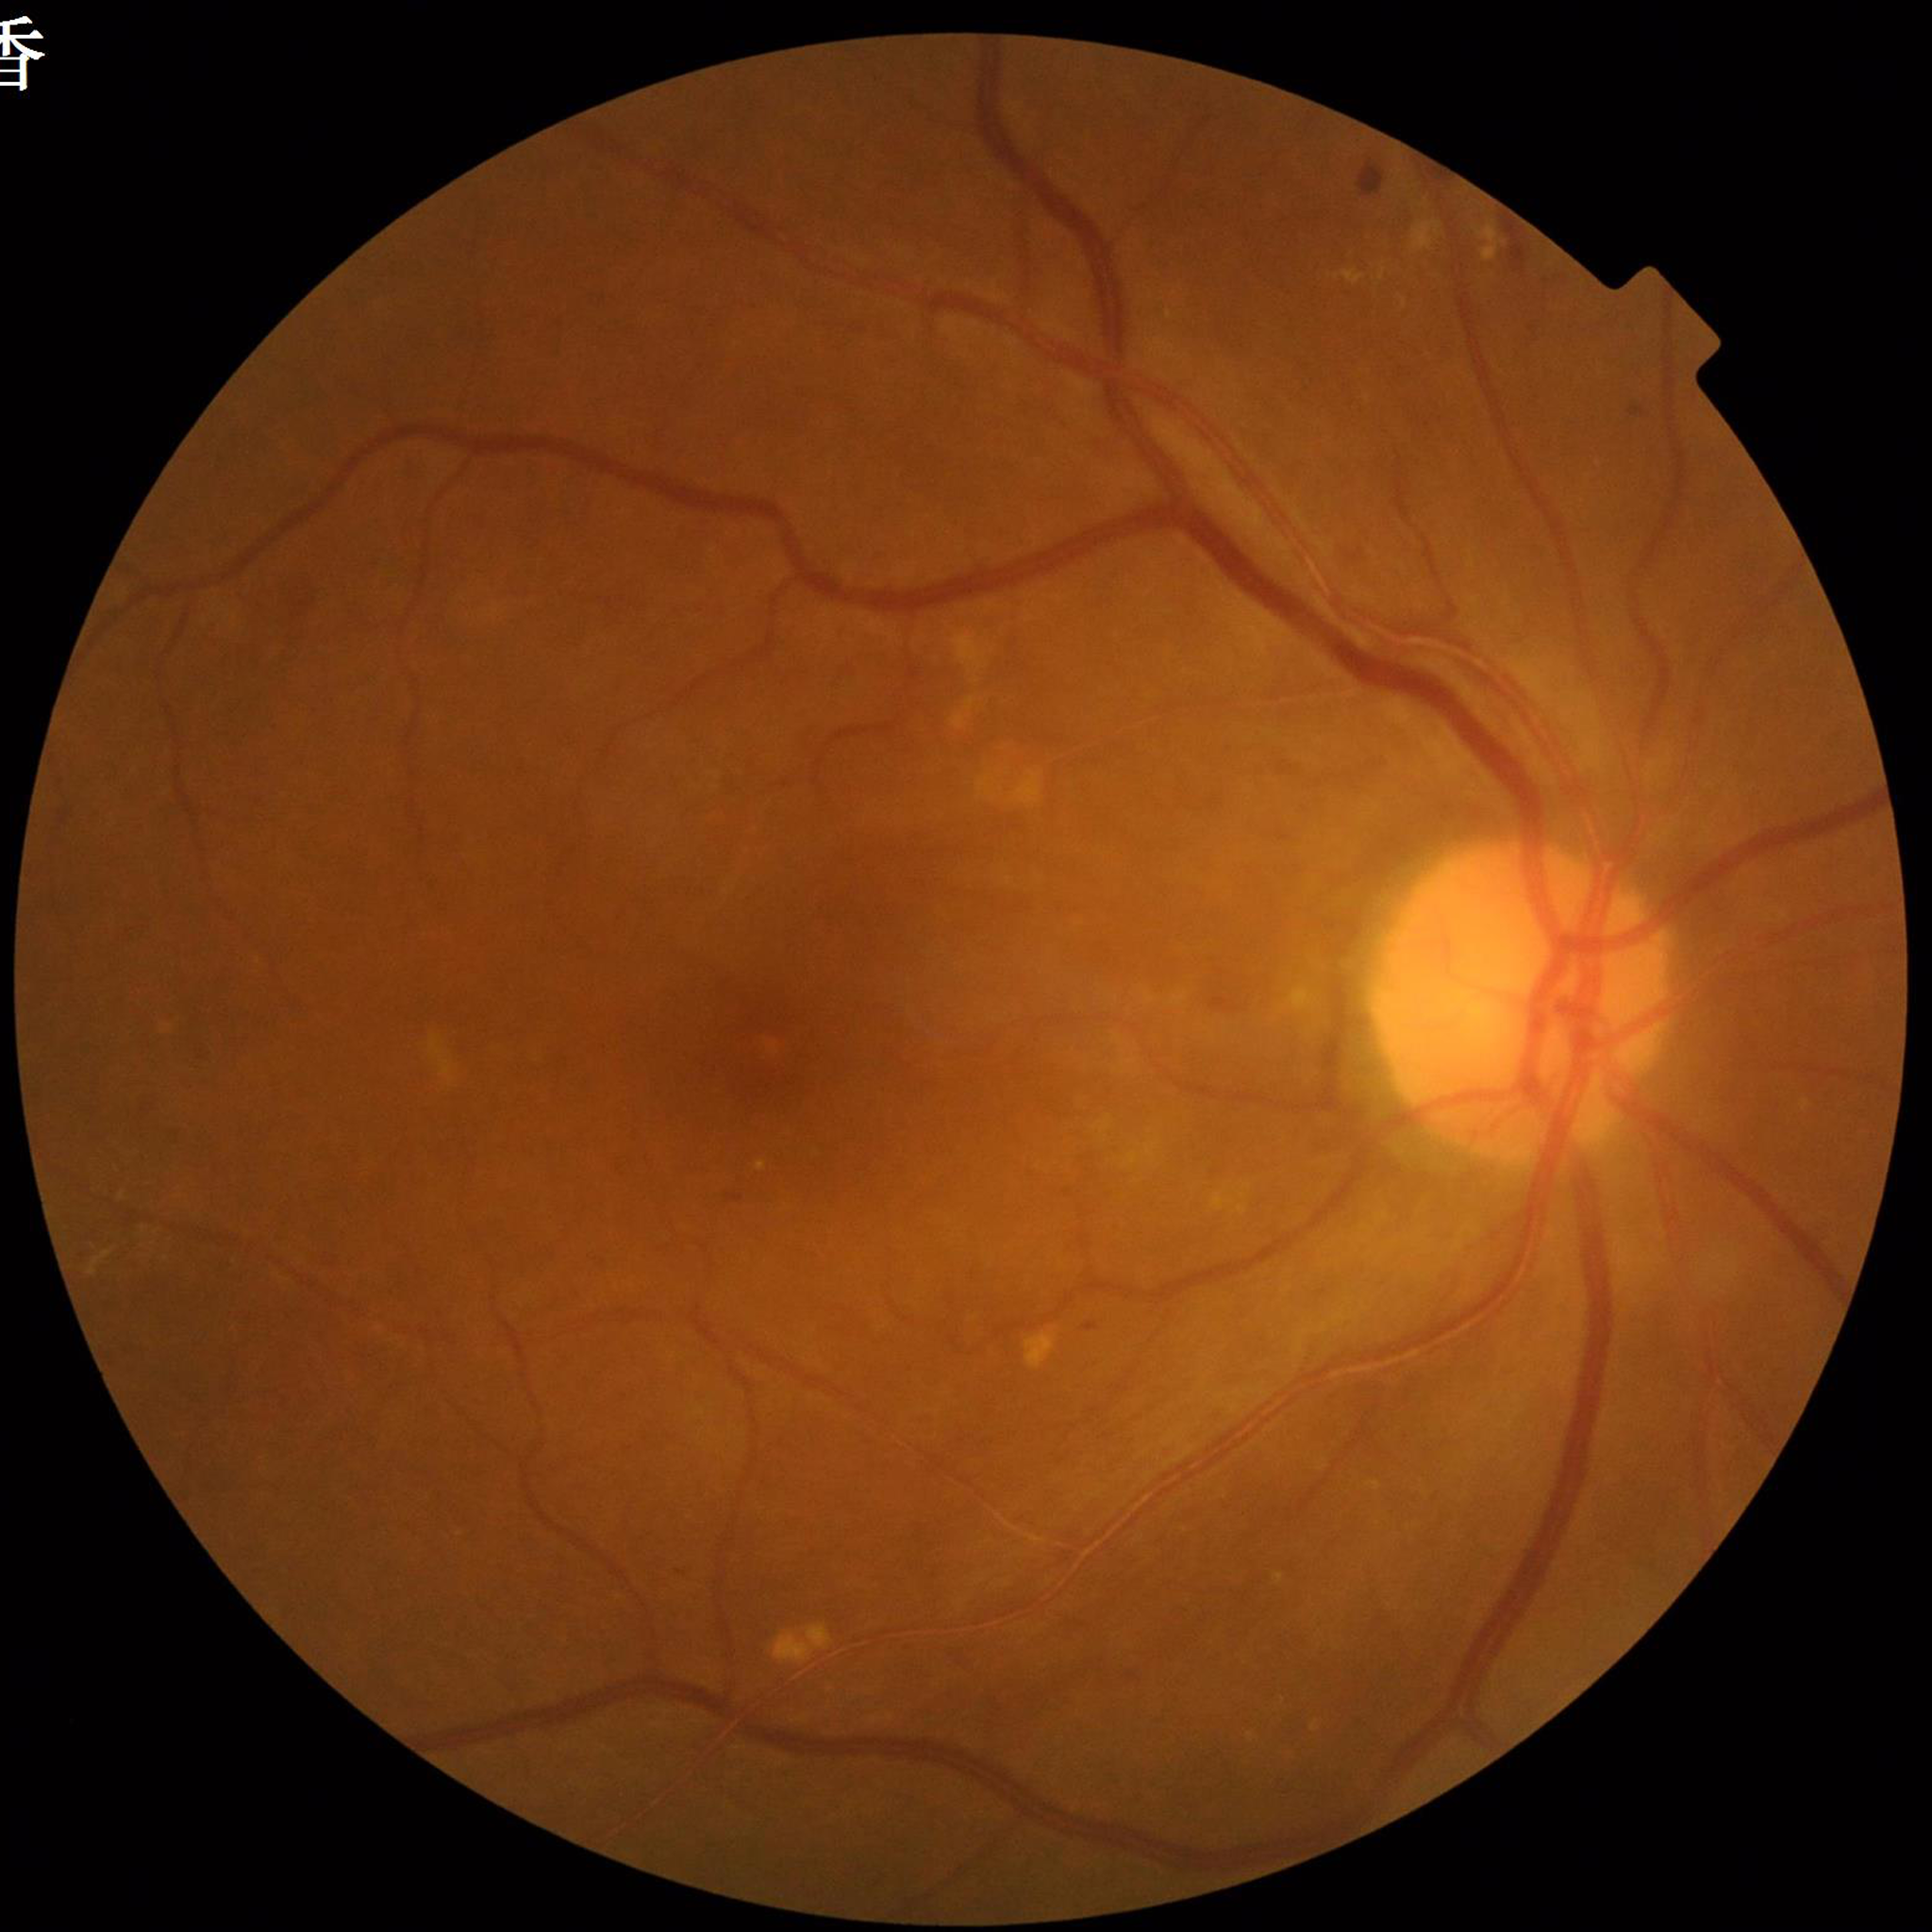 Condition = diabetic retinopathy.